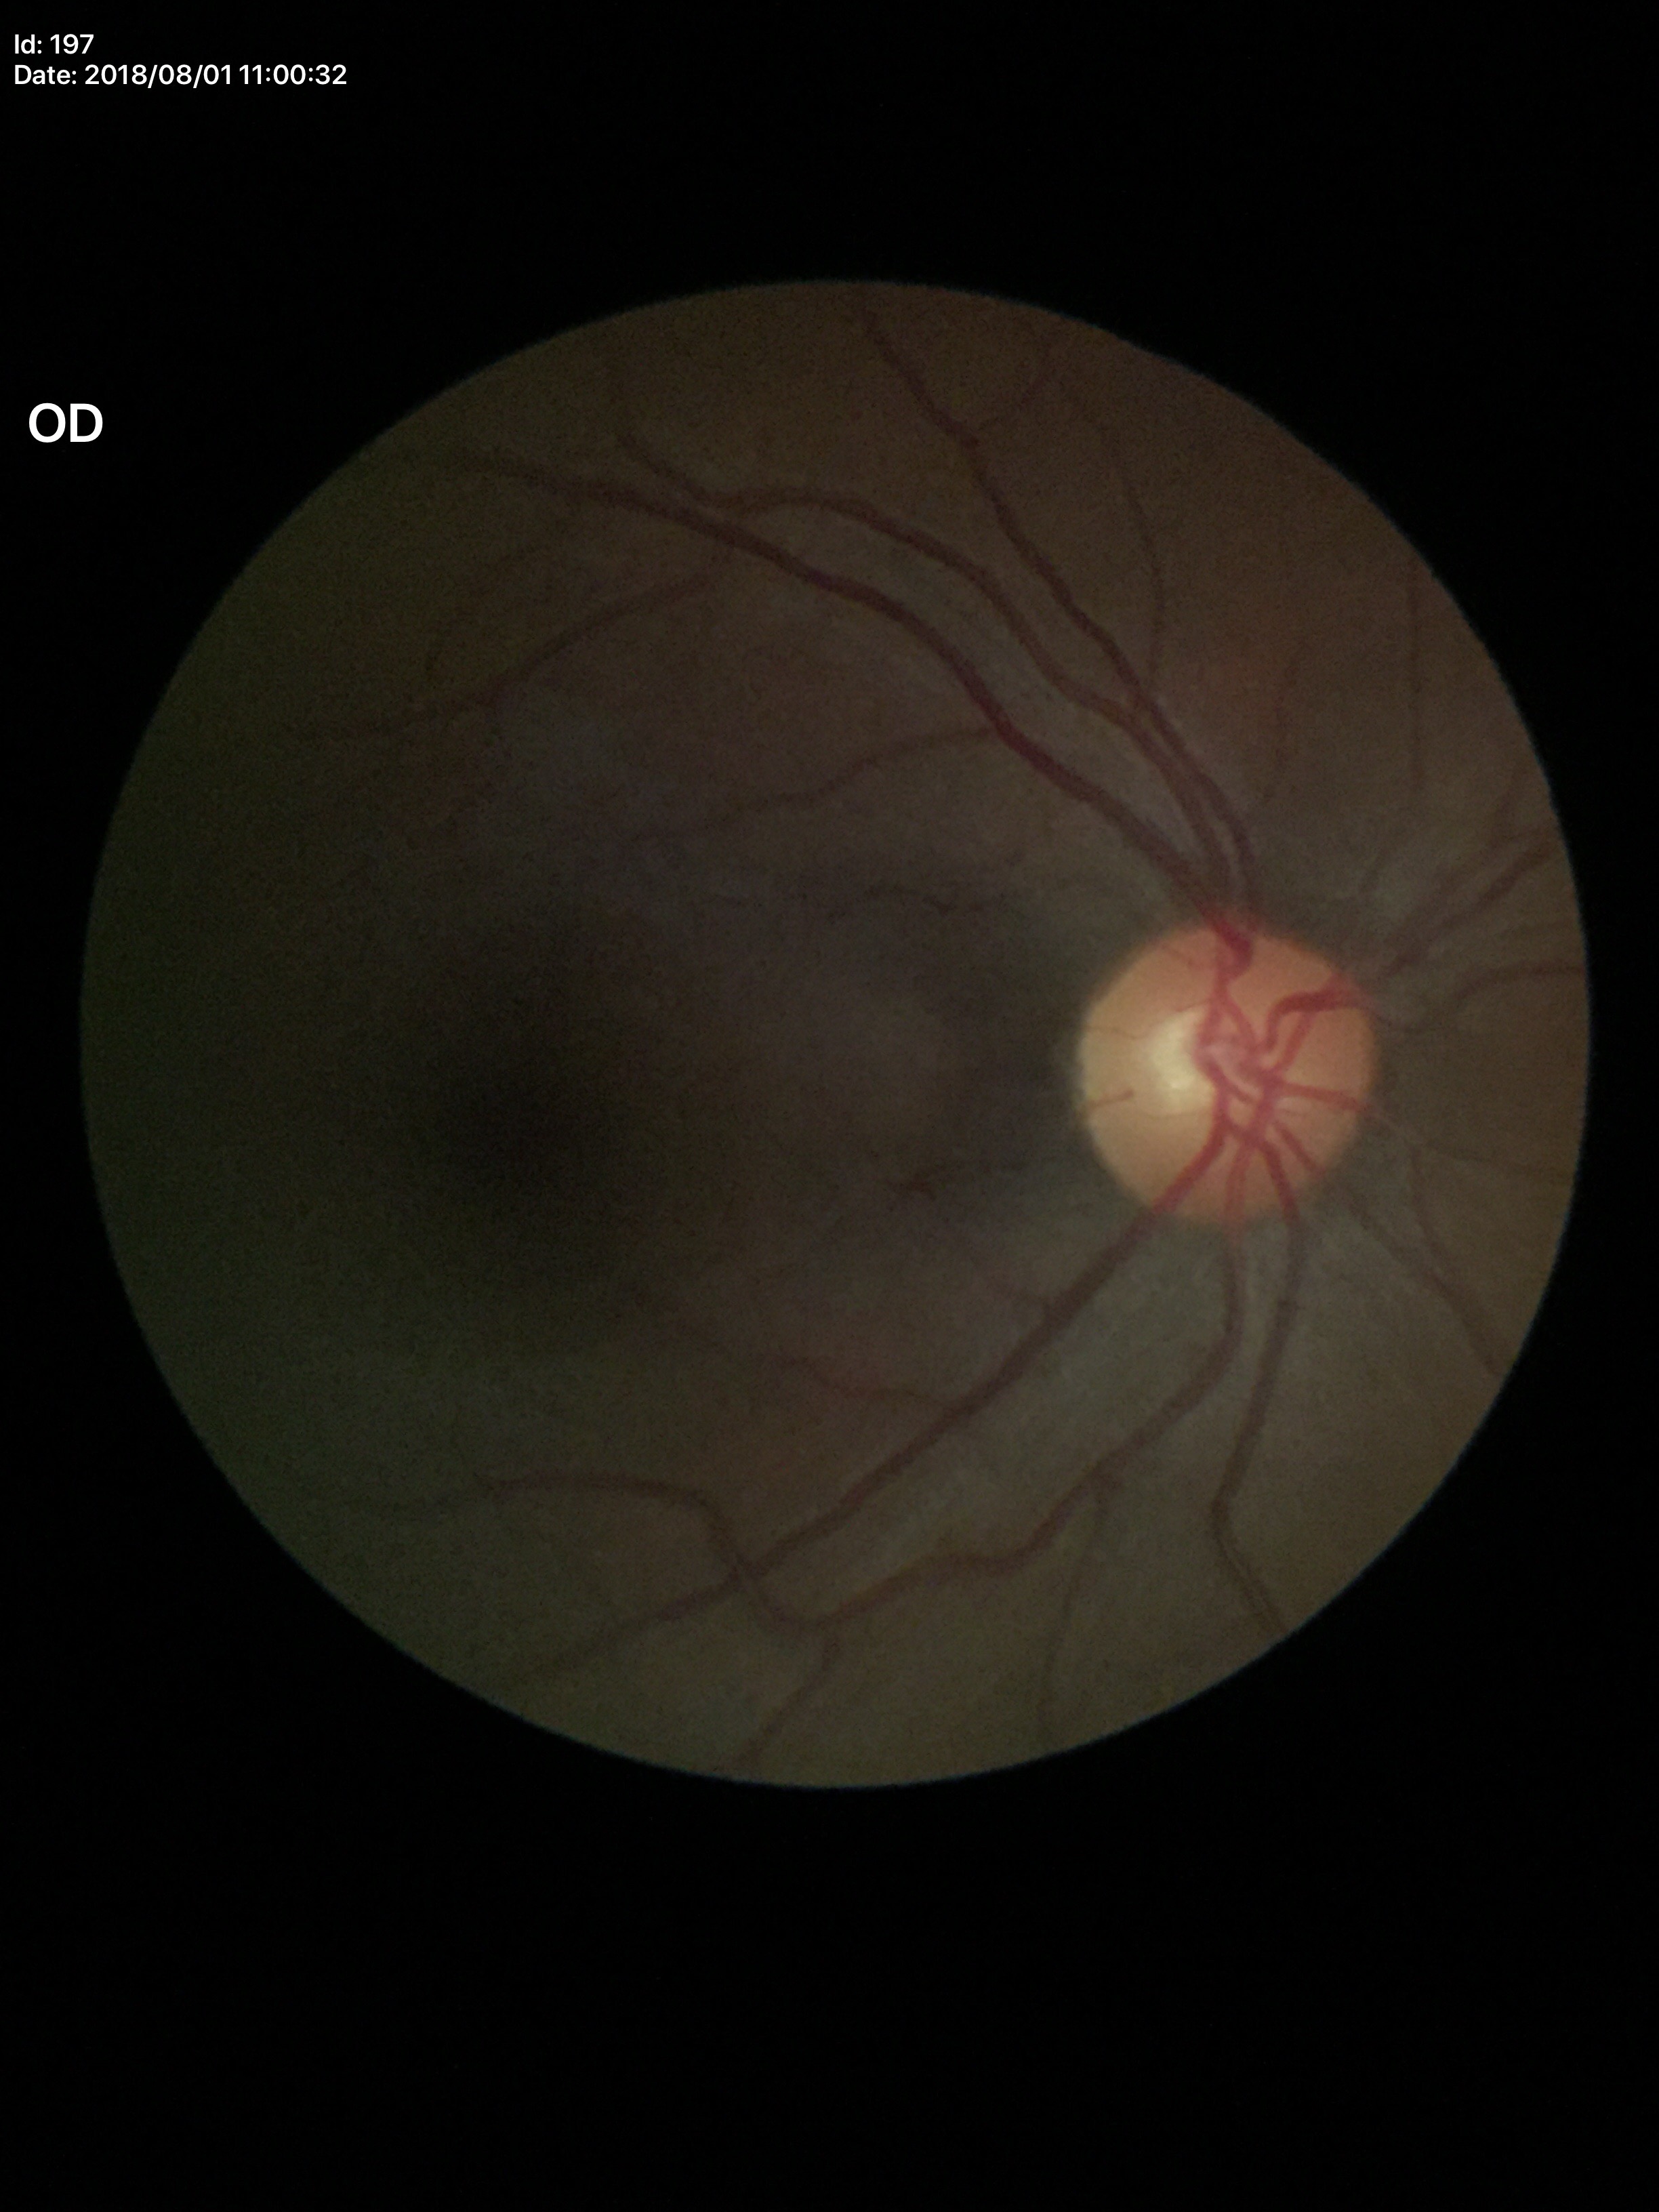 Glaucoma screening impression=not suspect (5/5 ophthalmologists in agreement) | vertical cup-disc ratio (VCDR)=0.48 | area cup-disc ratio (ACDR)=0.26